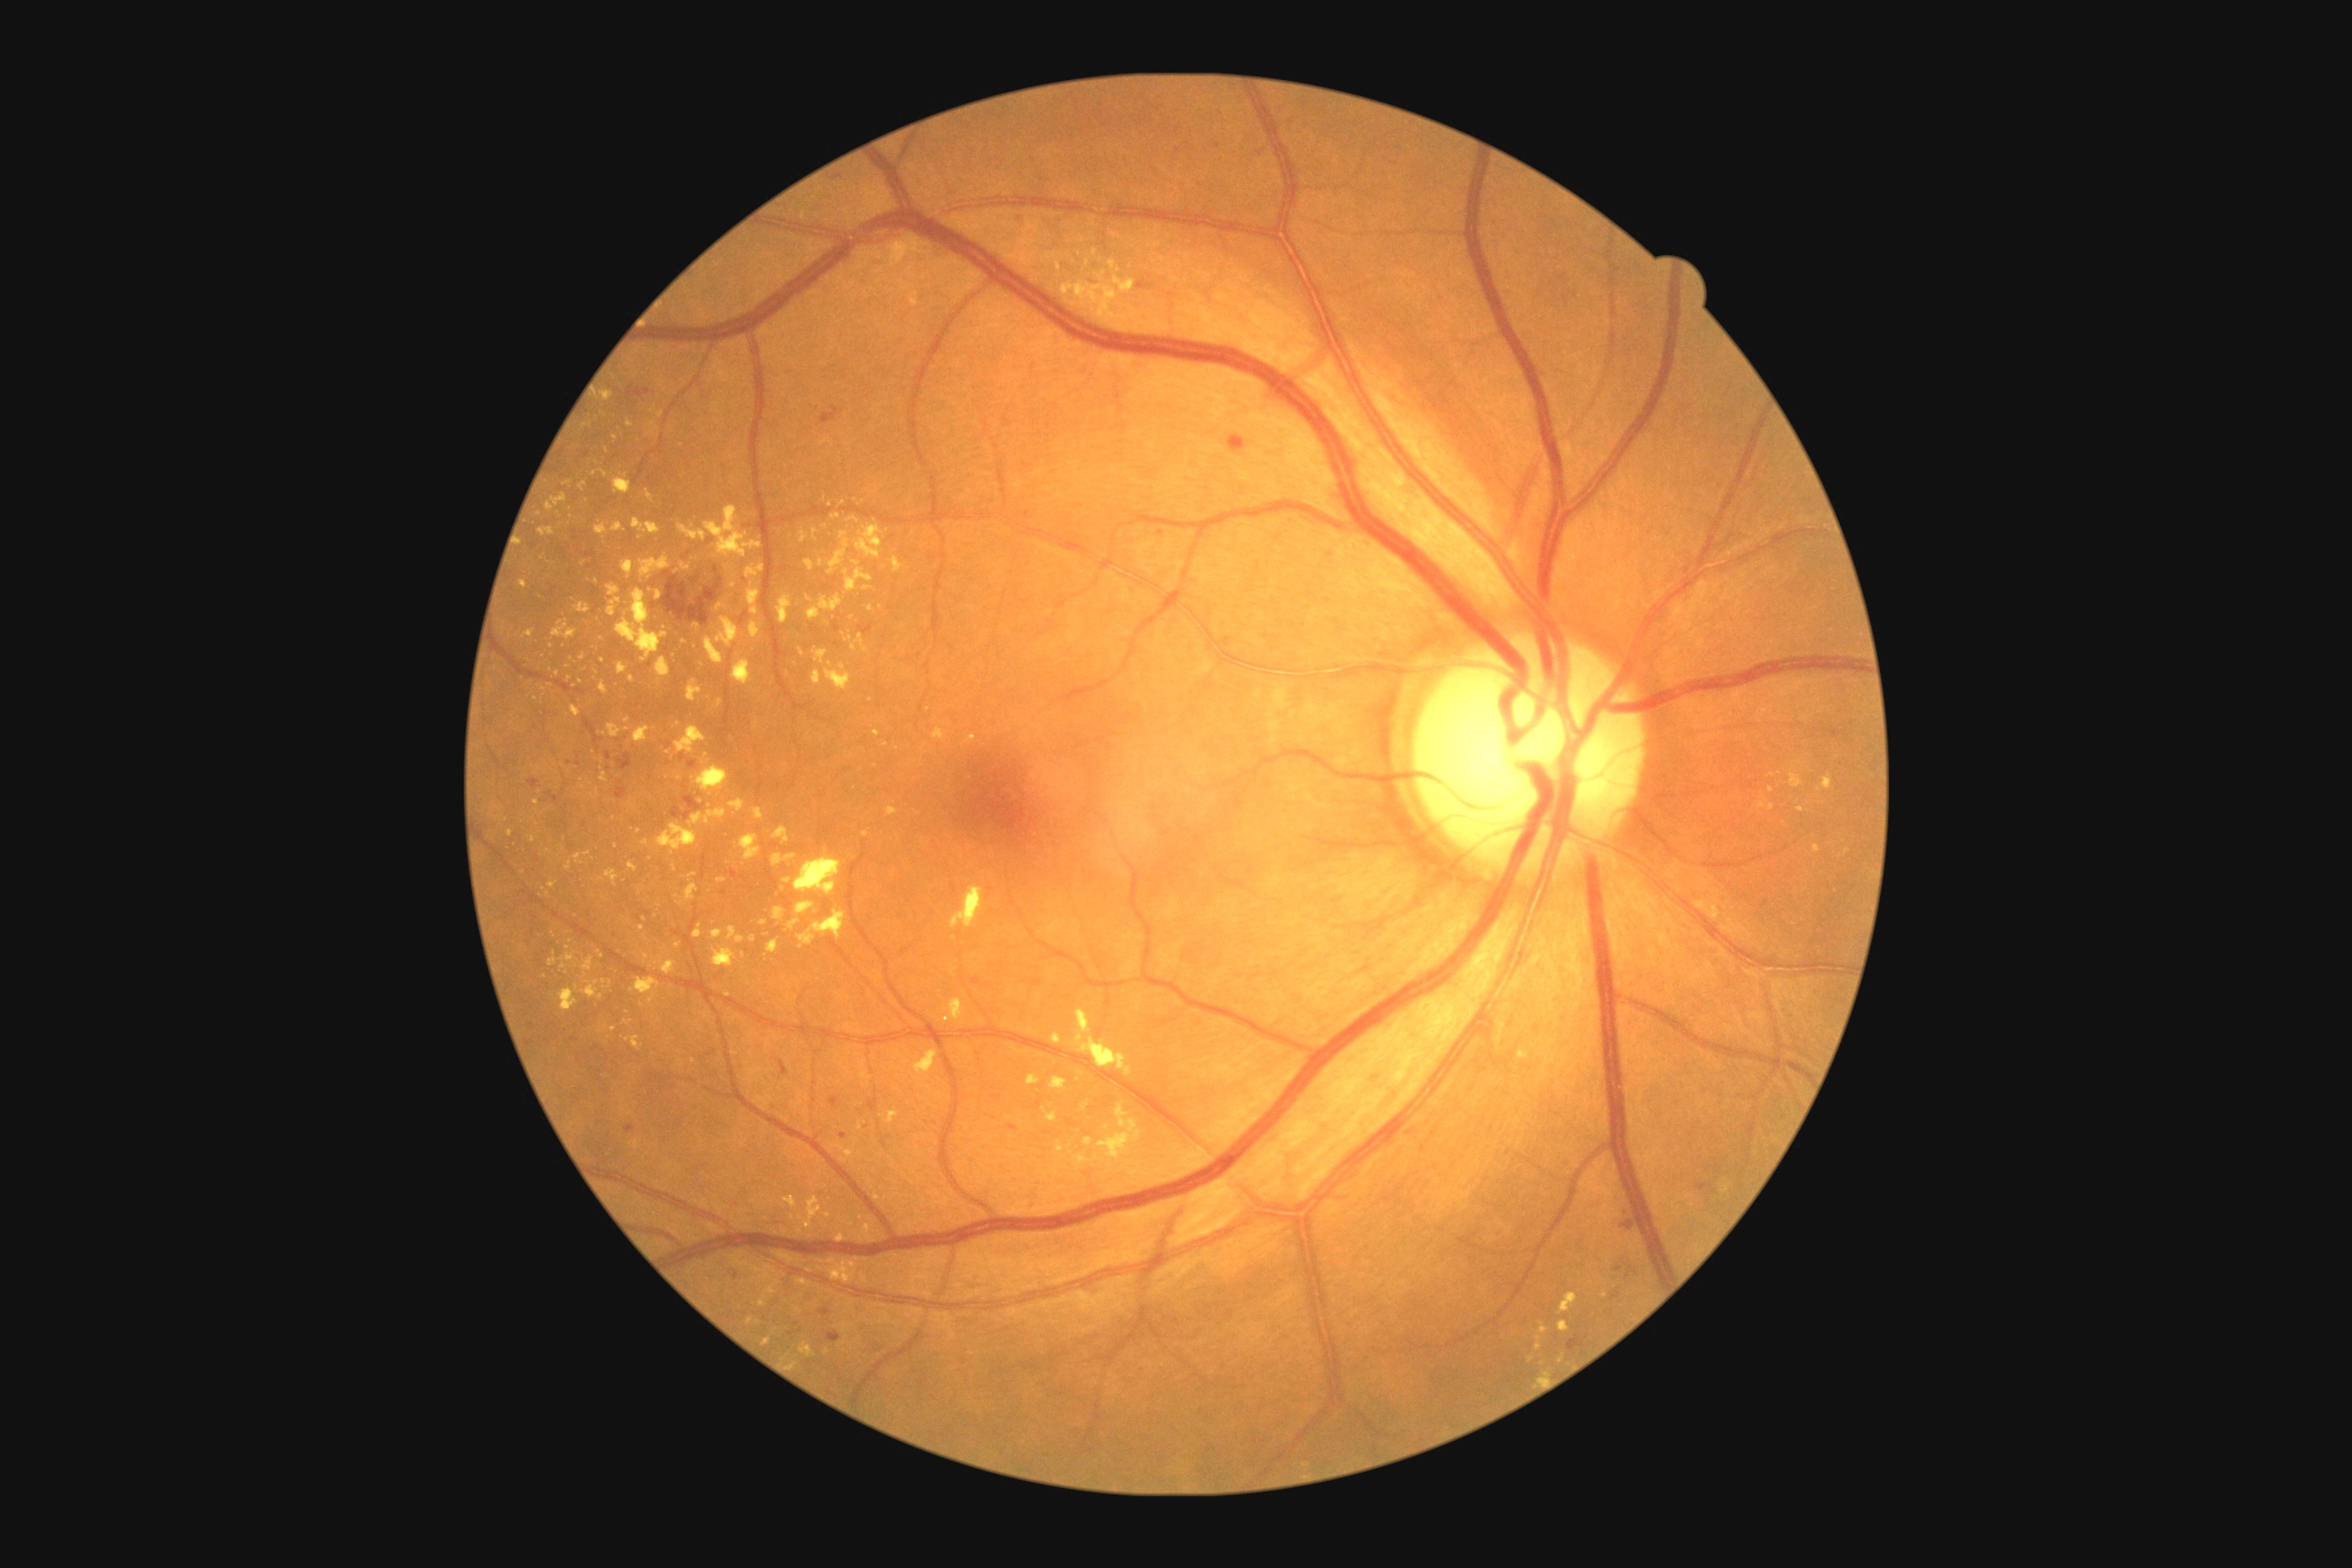

DR grade: moderate non-proliferative diabetic retinopathy (2)
Representative lesions:
EXs (continued): [left=799, top=1342, right=816, bottom=1358]; [left=1081, top=260, right=1135, bottom=295]; [left=571, top=705, right=582, bottom=718]; [left=778, top=596, right=792, bottom=623]; [left=750, top=622, right=761, bottom=640]; [left=629, top=863, right=638, bottom=872]; [left=678, top=524, right=709, bottom=542]; [left=600, top=681, right=609, bottom=694]; [left=783, top=879, right=792, bottom=885]; [left=841, top=1324, right=848, bottom=1333]
Smaller EXs around Point(878, 1197); Point(602, 660); Point(1539, 1338); Point(1082, 240); Point(750, 1320); Point(810, 1270); Point(616, 846); Point(571, 942); Point(819, 1269)